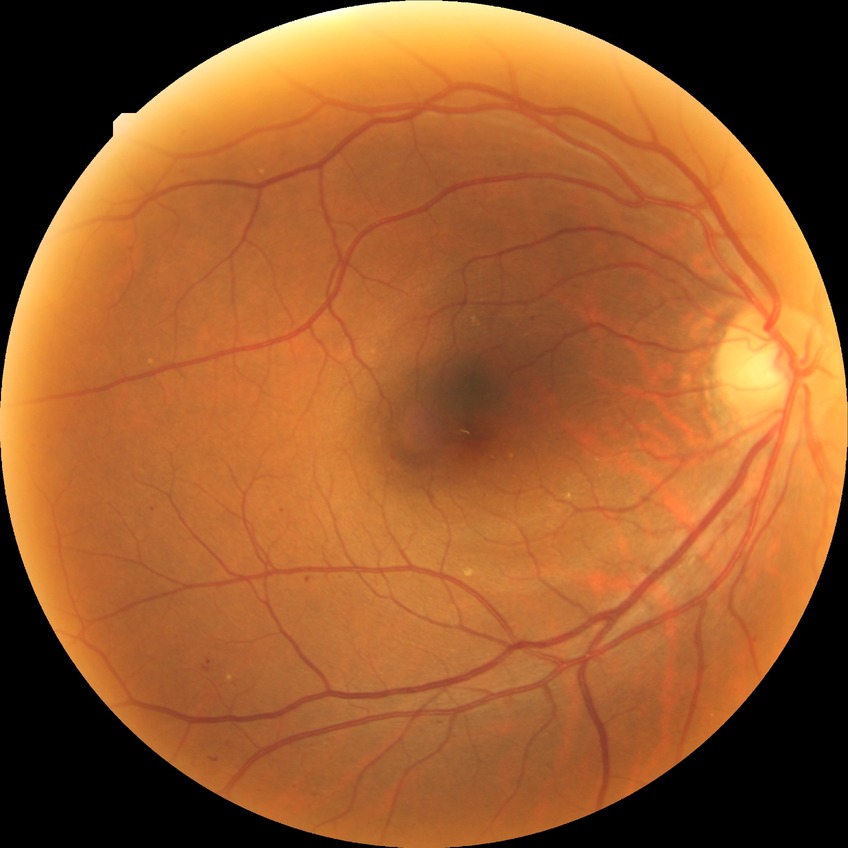 diabetic retinopathy (DR): simple diabetic retinopathy (SDR).